Camera: Clarity RetCam 3 (130° FOV); pediatric retinal photograph (wide-field); 640x480px
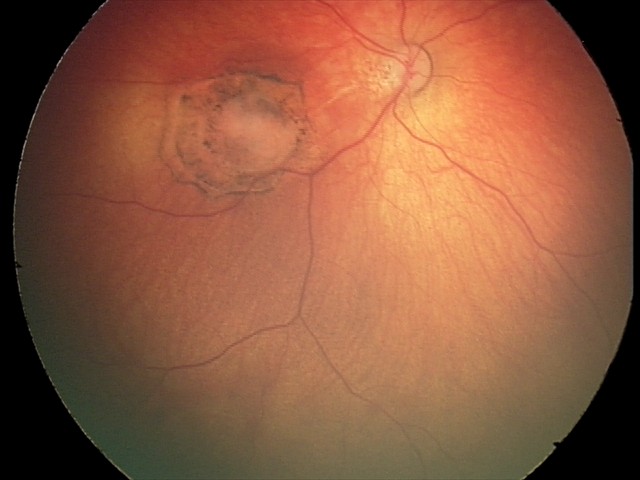 Impression: toxoplasmosis chorioretinitis.